Color fundus photograph. NIDEK AFC-230 fundus camera. 45° field of view. Diabetic retinopathy graded by the modified Davis classification
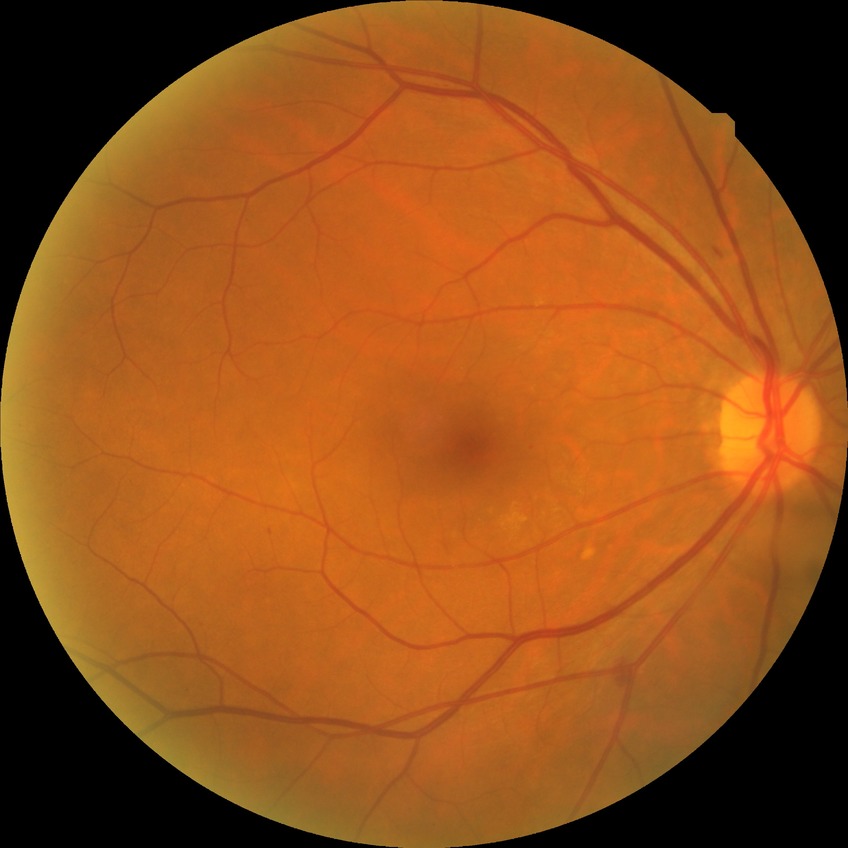
Modified Davis grading: simple diabetic retinopathy.